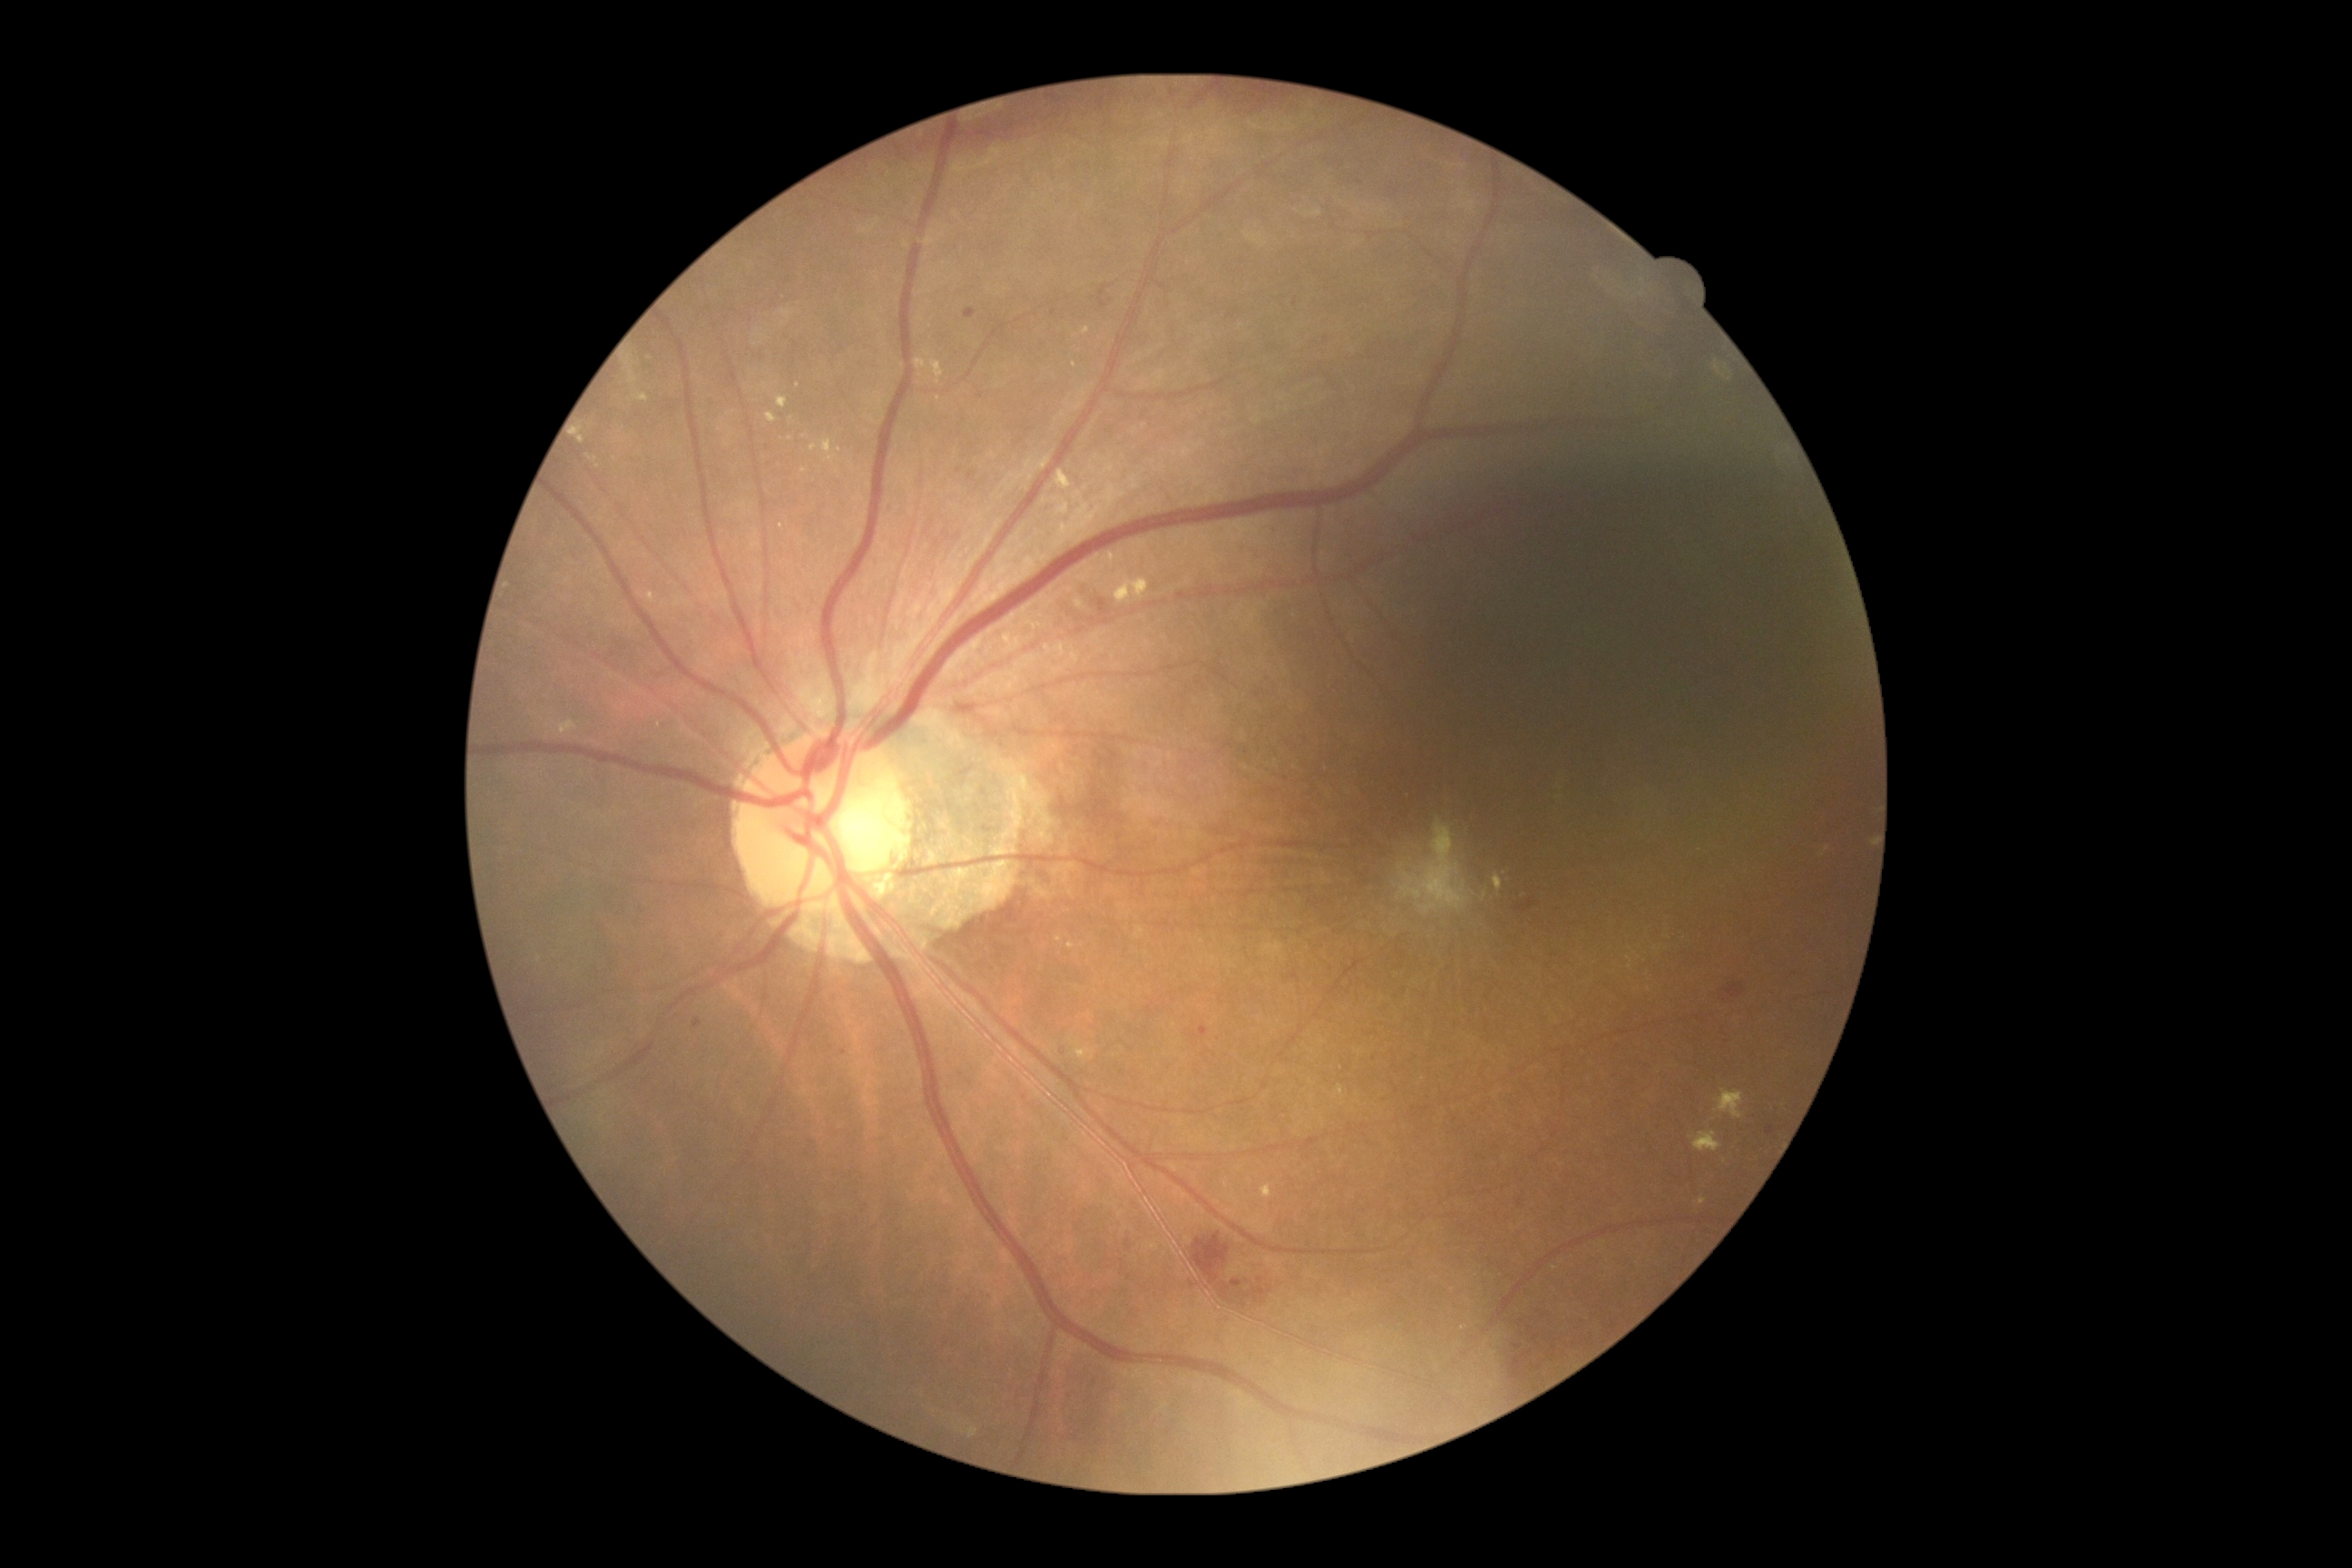 Diabetic retinopathy (DR): moderate NPDR (grade 2); non-proliferative diabetic retinopathy
A subset of detected lesions:
hemorrhages (HEs) (partial): (left=1723, top=985, right=1745, bottom=999); (left=1048, top=583, right=1119, bottom=629); (left=1057, top=1044, right=1070, bottom=1057); (left=694, top=1019, right=701, bottom=1030); (left=1190, top=1231, right=1279, bottom=1313); (left=1514, top=1346, right=1522, bottom=1351); (left=979, top=1289, right=995, bottom=1302); (left=1767, top=1126, right=1774, bottom=1137); (left=1097, top=286, right=1106, bottom=309); (left=1199, top=1026, right=1208, bottom=1037); (left=1518, top=1199, right=1522, bottom=1208); (left=1511, top=1351, right=1534, bottom=1380); (left=965, top=309, right=977, bottom=320); (left=1514, top=899, right=1536, bottom=914); (left=897, top=88, right=1306, bottom=161); (left=977, top=393, right=985, bottom=398)
Small HEs approximately at [845,1053]; [1054,314]
hard exudates (EXs) (partial): (left=916, top=358, right=928, bottom=369); (left=932, top=360, right=945, bottom=386); (left=767, top=413, right=778, bottom=424); (left=647, top=591, right=660, bottom=607); (left=1112, top=576, right=1150, bottom=607); (left=1064, top=941, right=1079, bottom=954); (left=1139, top=542, right=1148, bottom=547); (left=1700, top=1197, right=1707, bottom=1206); (left=999, top=631, right=1017, bottom=649); (left=1260, top=1186, right=1273, bottom=1199); (left=623, top=355, right=638, bottom=386)
Small EXs approximately at [805,436]; [798,386]; [590,458]
microaneurysms (MAs): none detected
soft exudates (SEs): none detected